45° field of view:
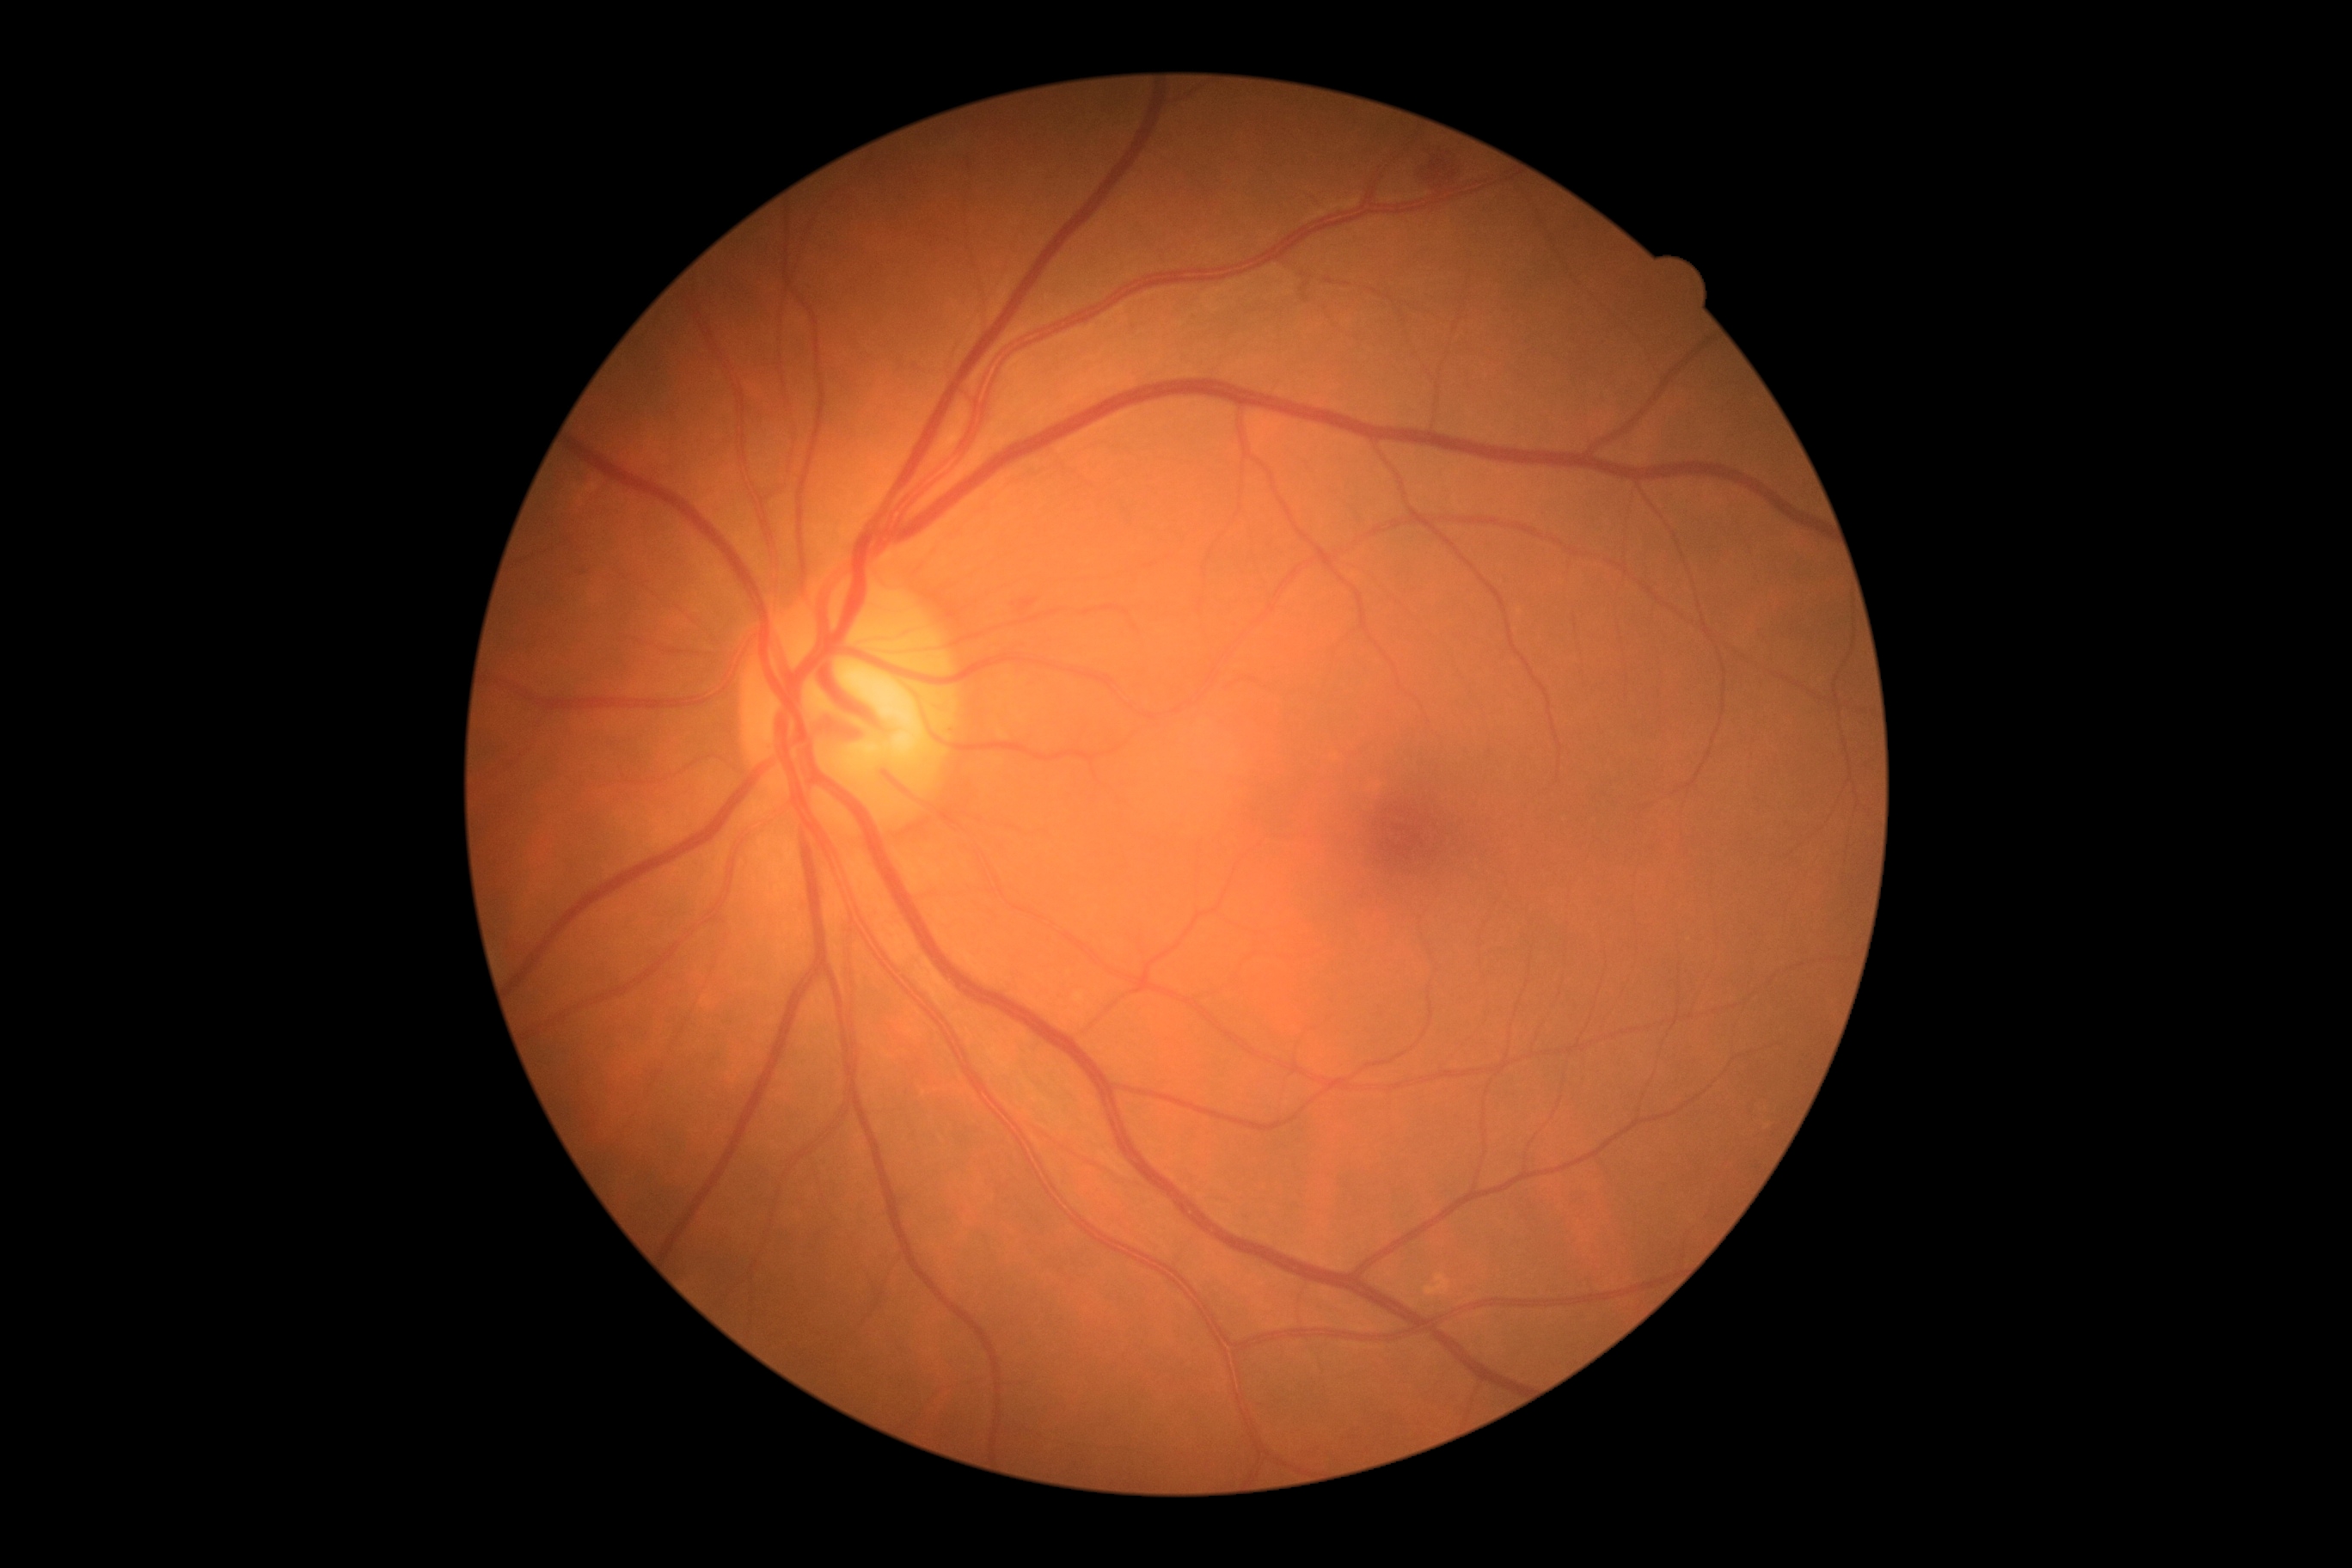
diabetic retinopathy (DR): grade 2 (moderate NPDR).